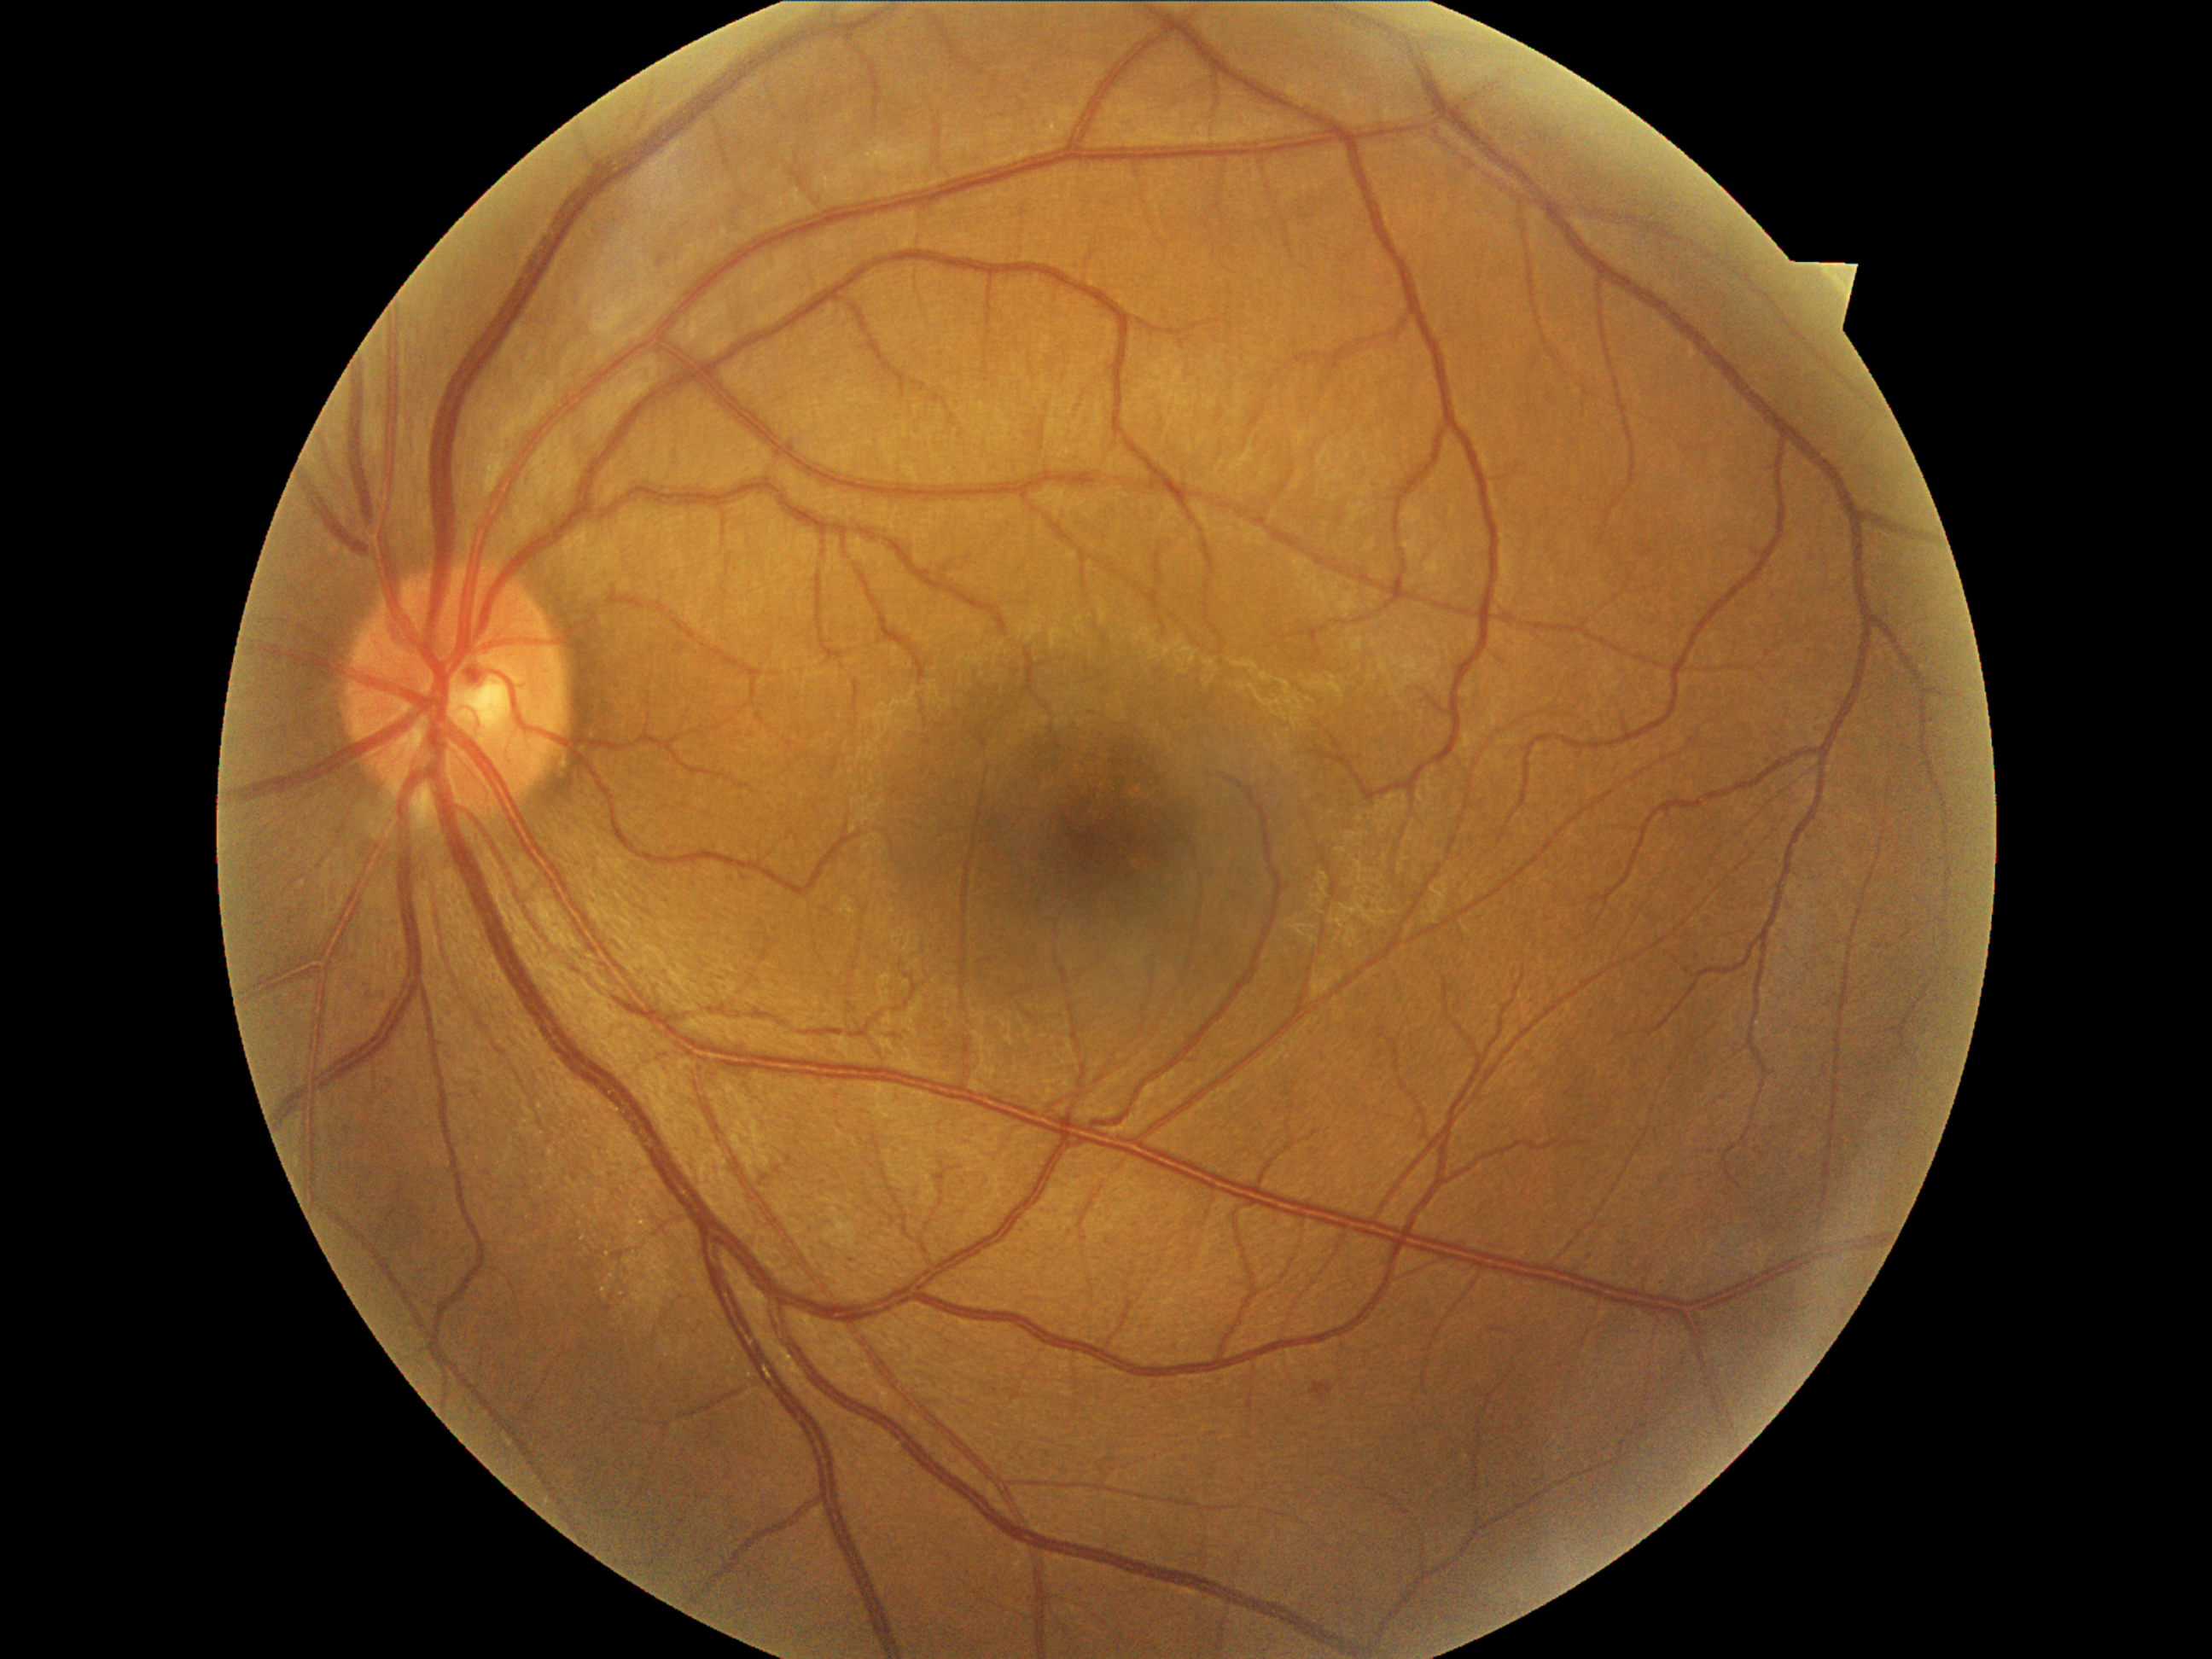
Diabetic retinopathy (DR) is grade 1 (mild NPDR). Microaneurysms (MAs) located at <bbox>1310, 1382, 1336, 1400</bbox>. Additional small MAs near point(661, 262). No soft exudates (SEs) identified. No hard exudates (EXs) identified. No hemorrhages (HEs) identified.